No pharmacologic dilation:
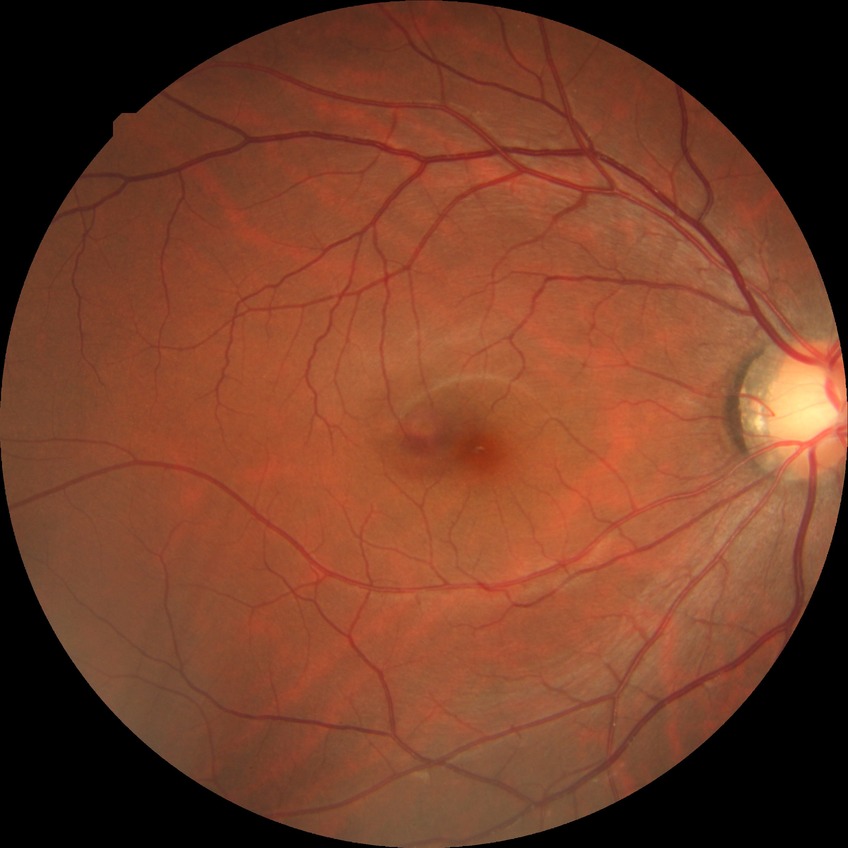

retinopathy stage: no diabetic retinopathy.